Wide-field fundus photograph from neonatal ROP screening.
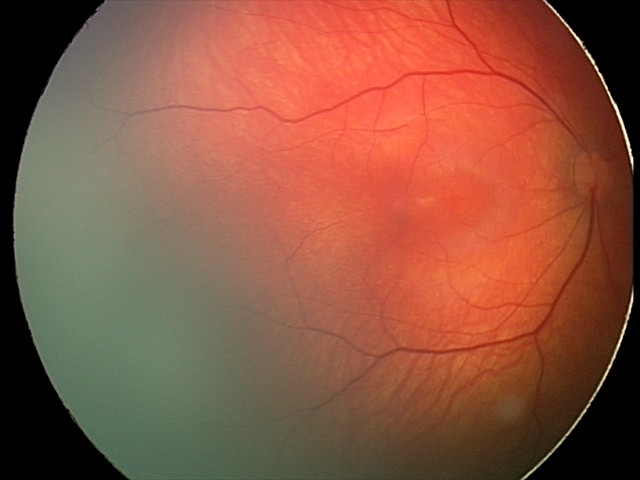

Series diagnosed as retinal hemorrhages.